Without pupil dilation
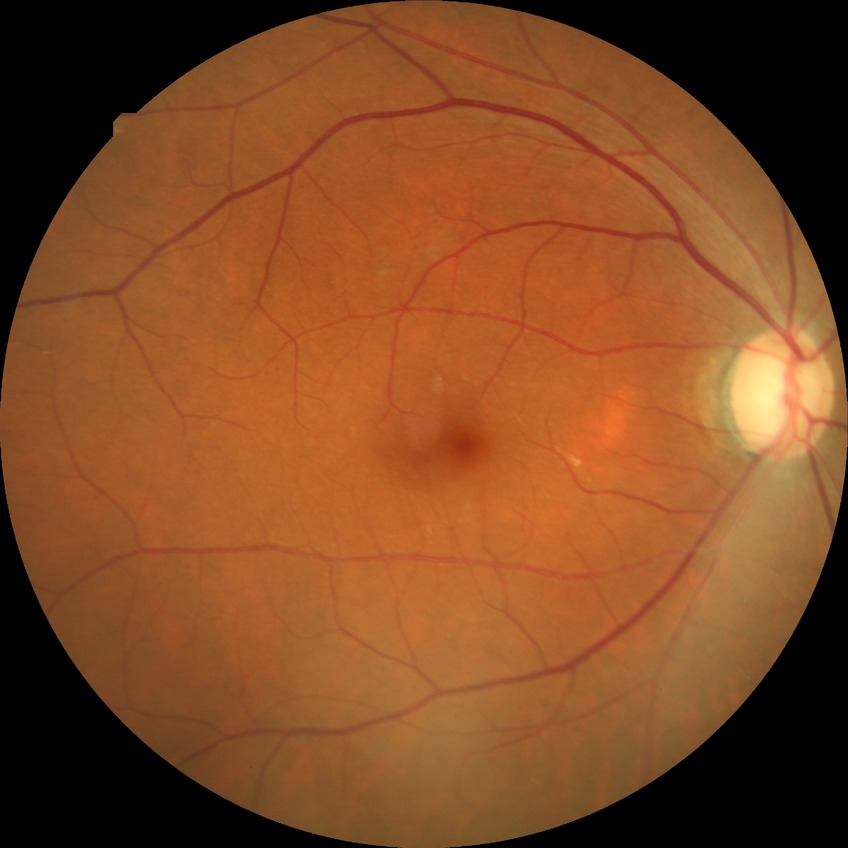
diabetic retinopathy (DR): SDR (simple diabetic retinopathy).